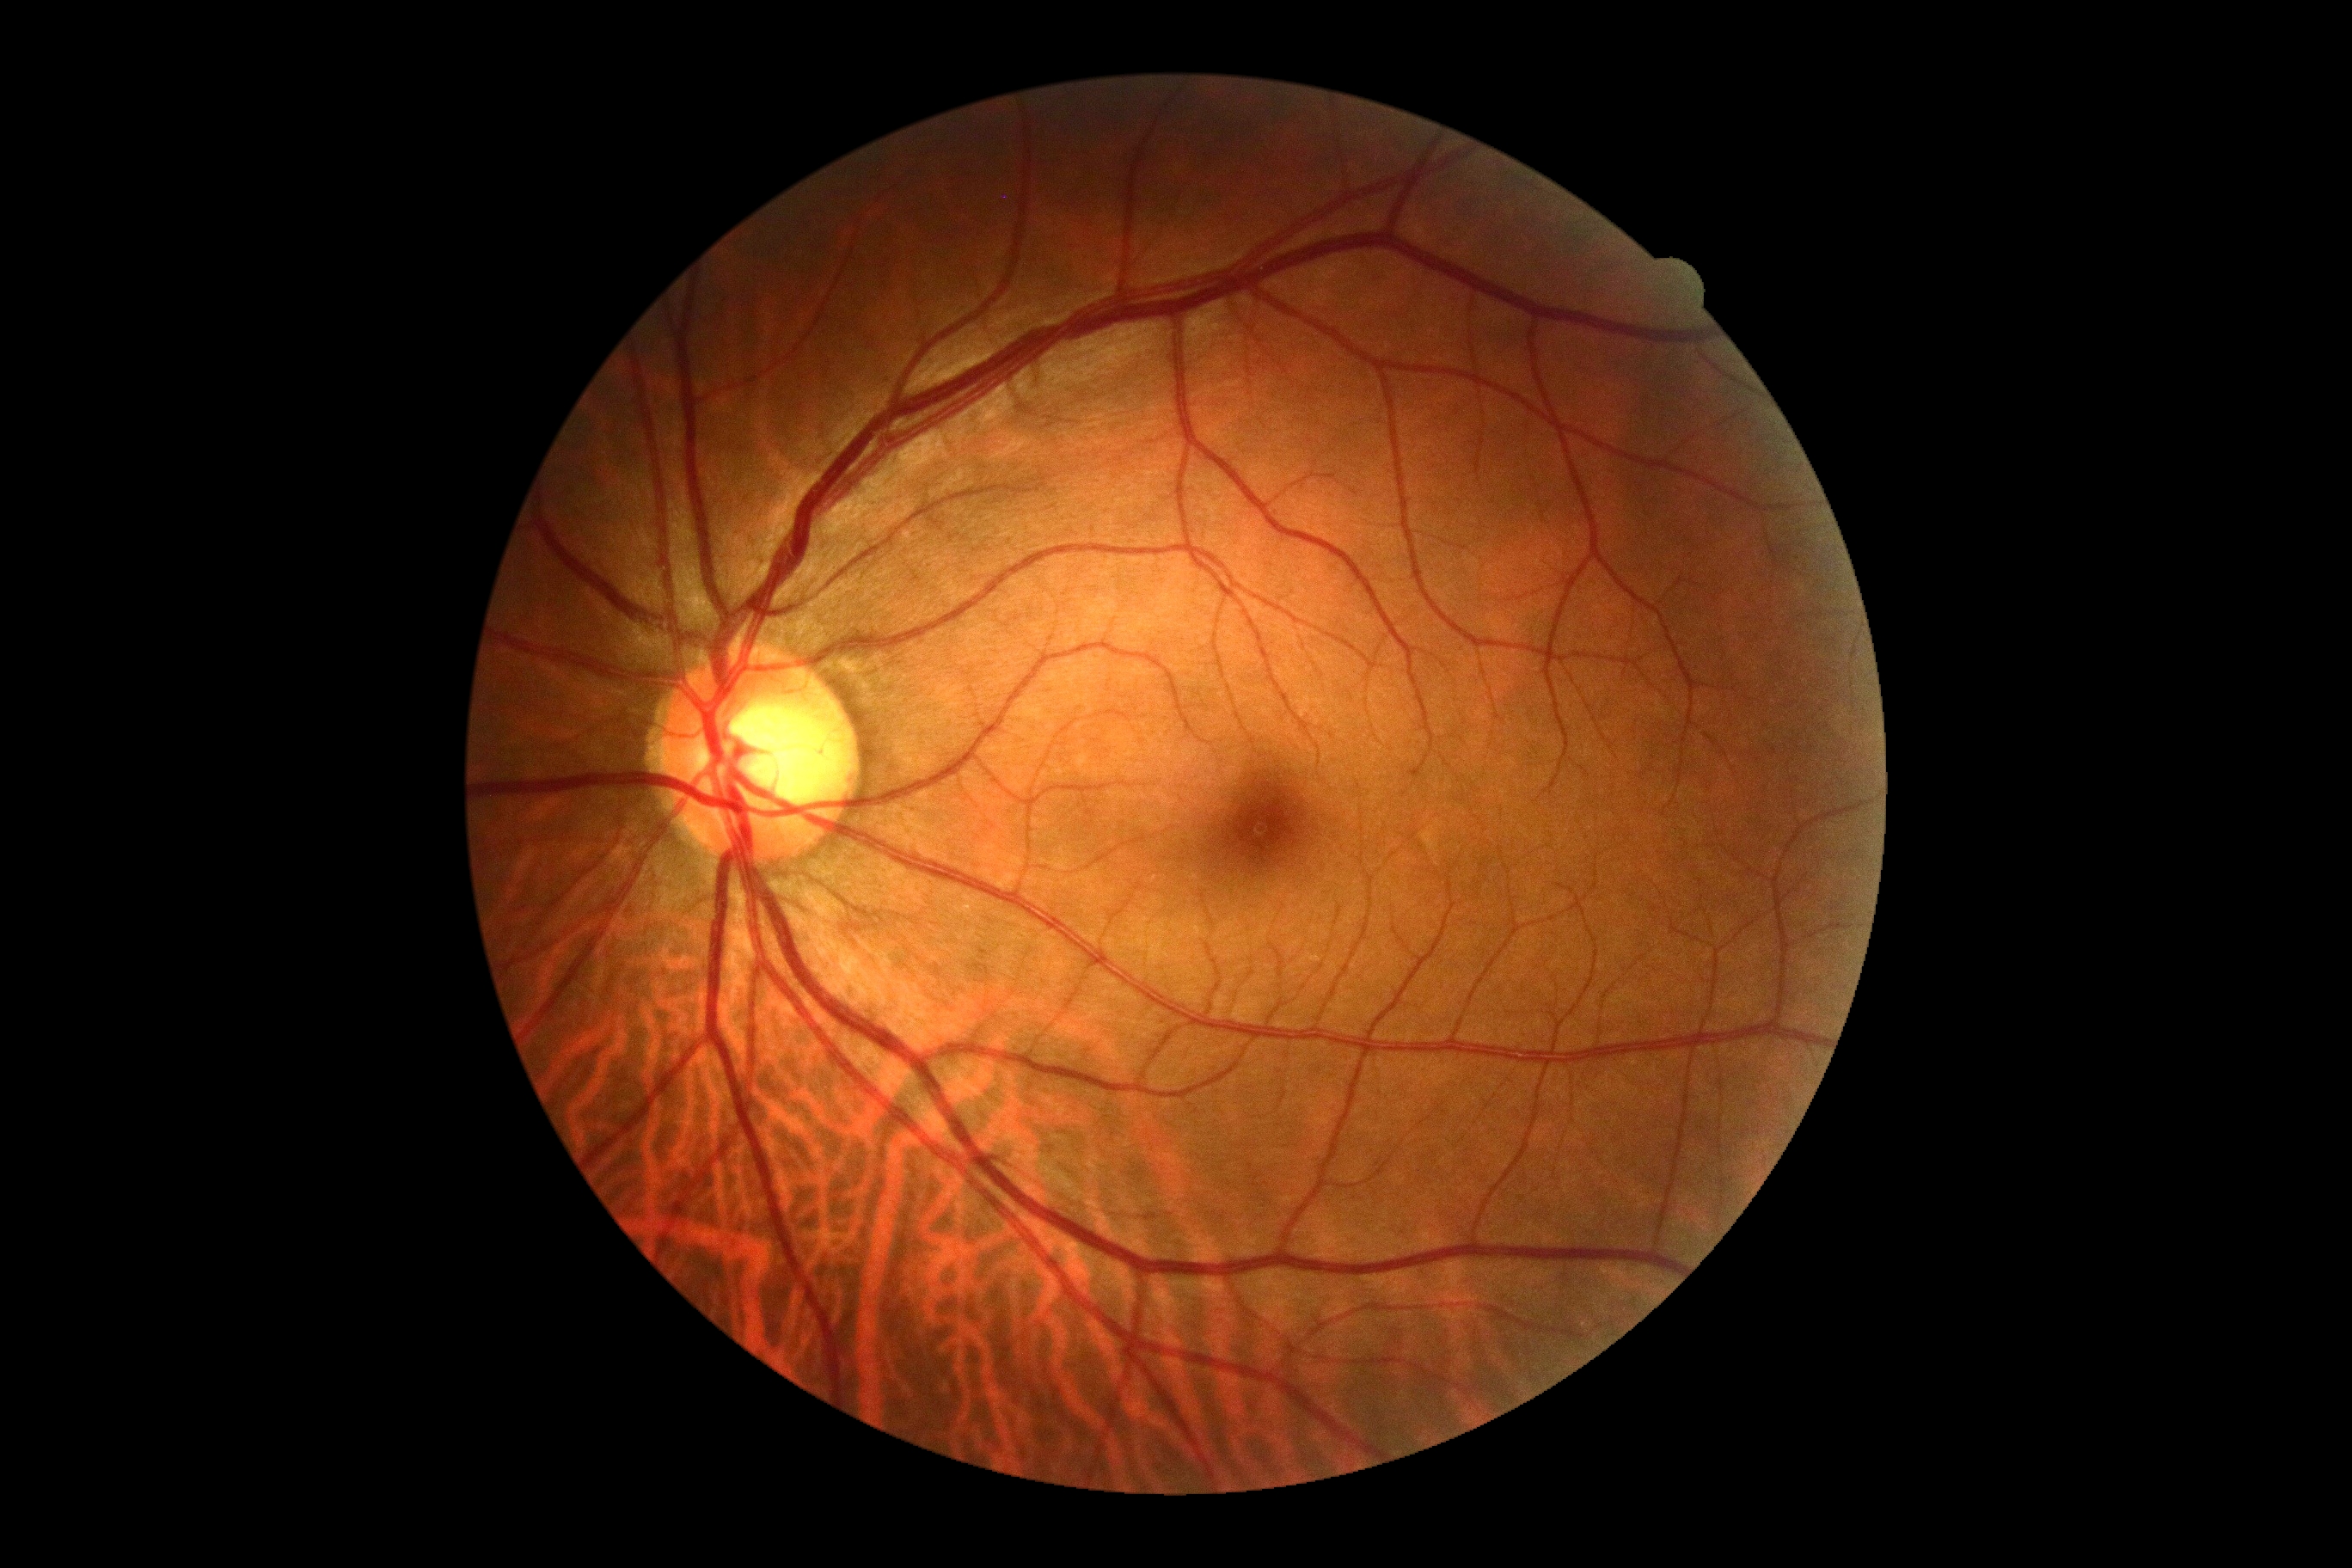 DR@0/4.